Color fundus photograph. No pharmacologic dilation. Modified Davis classification
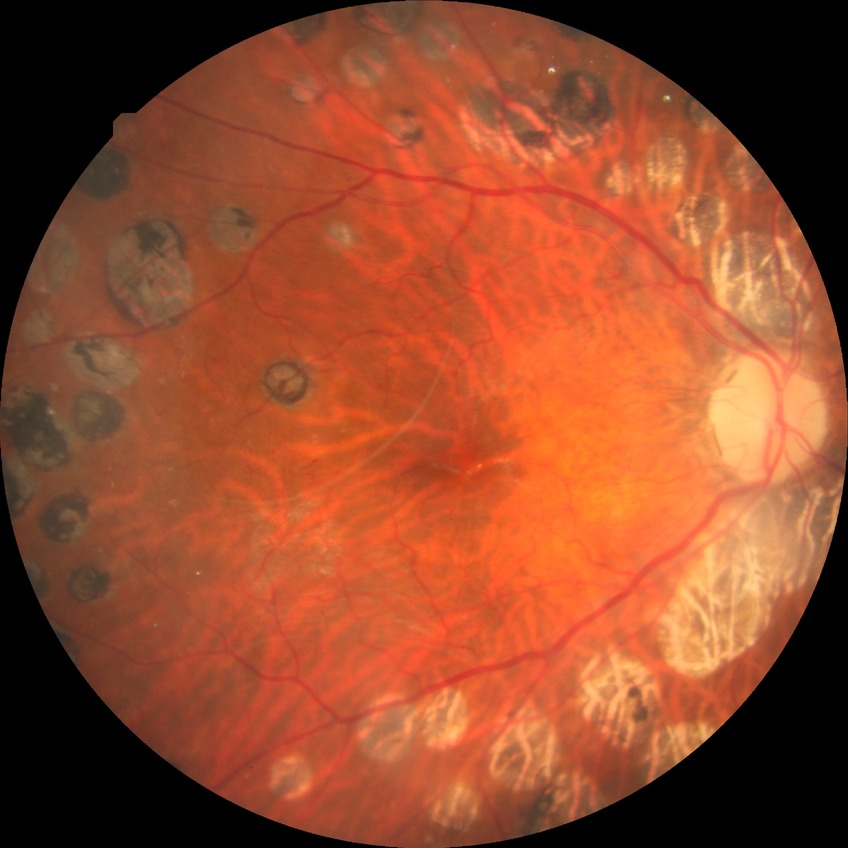 Diabetic retinopathy severity is proliferative diabetic retinopathy.